DR severity per modified Davis staging:
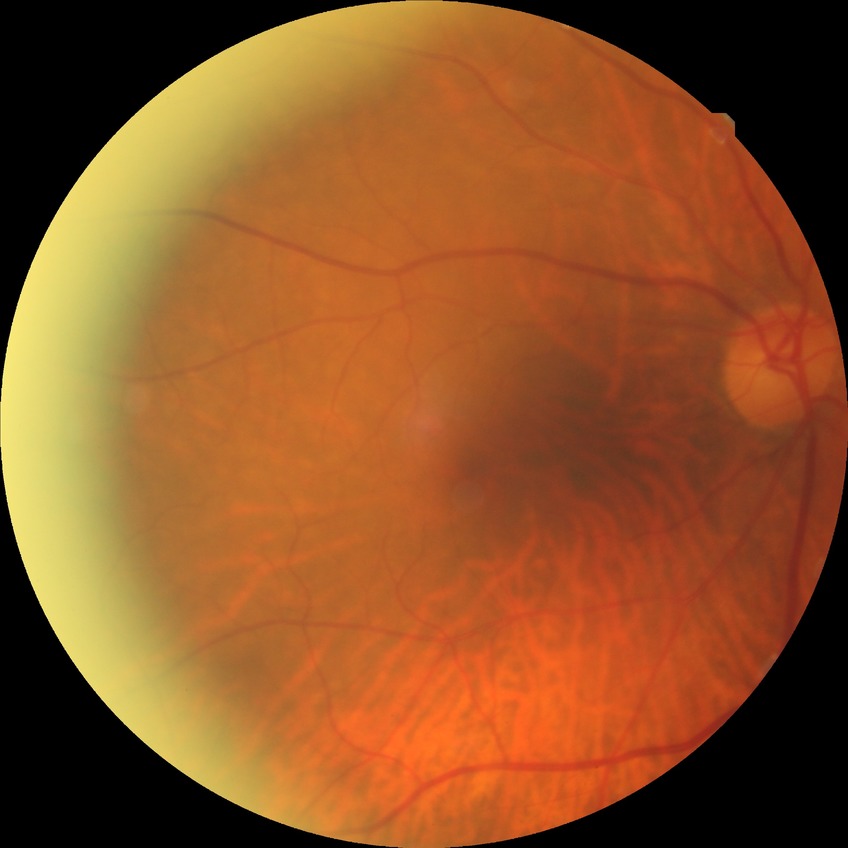 Davis stage: NDR.
No diabetic retinal disease findings.